1380 by 1382 pixels: 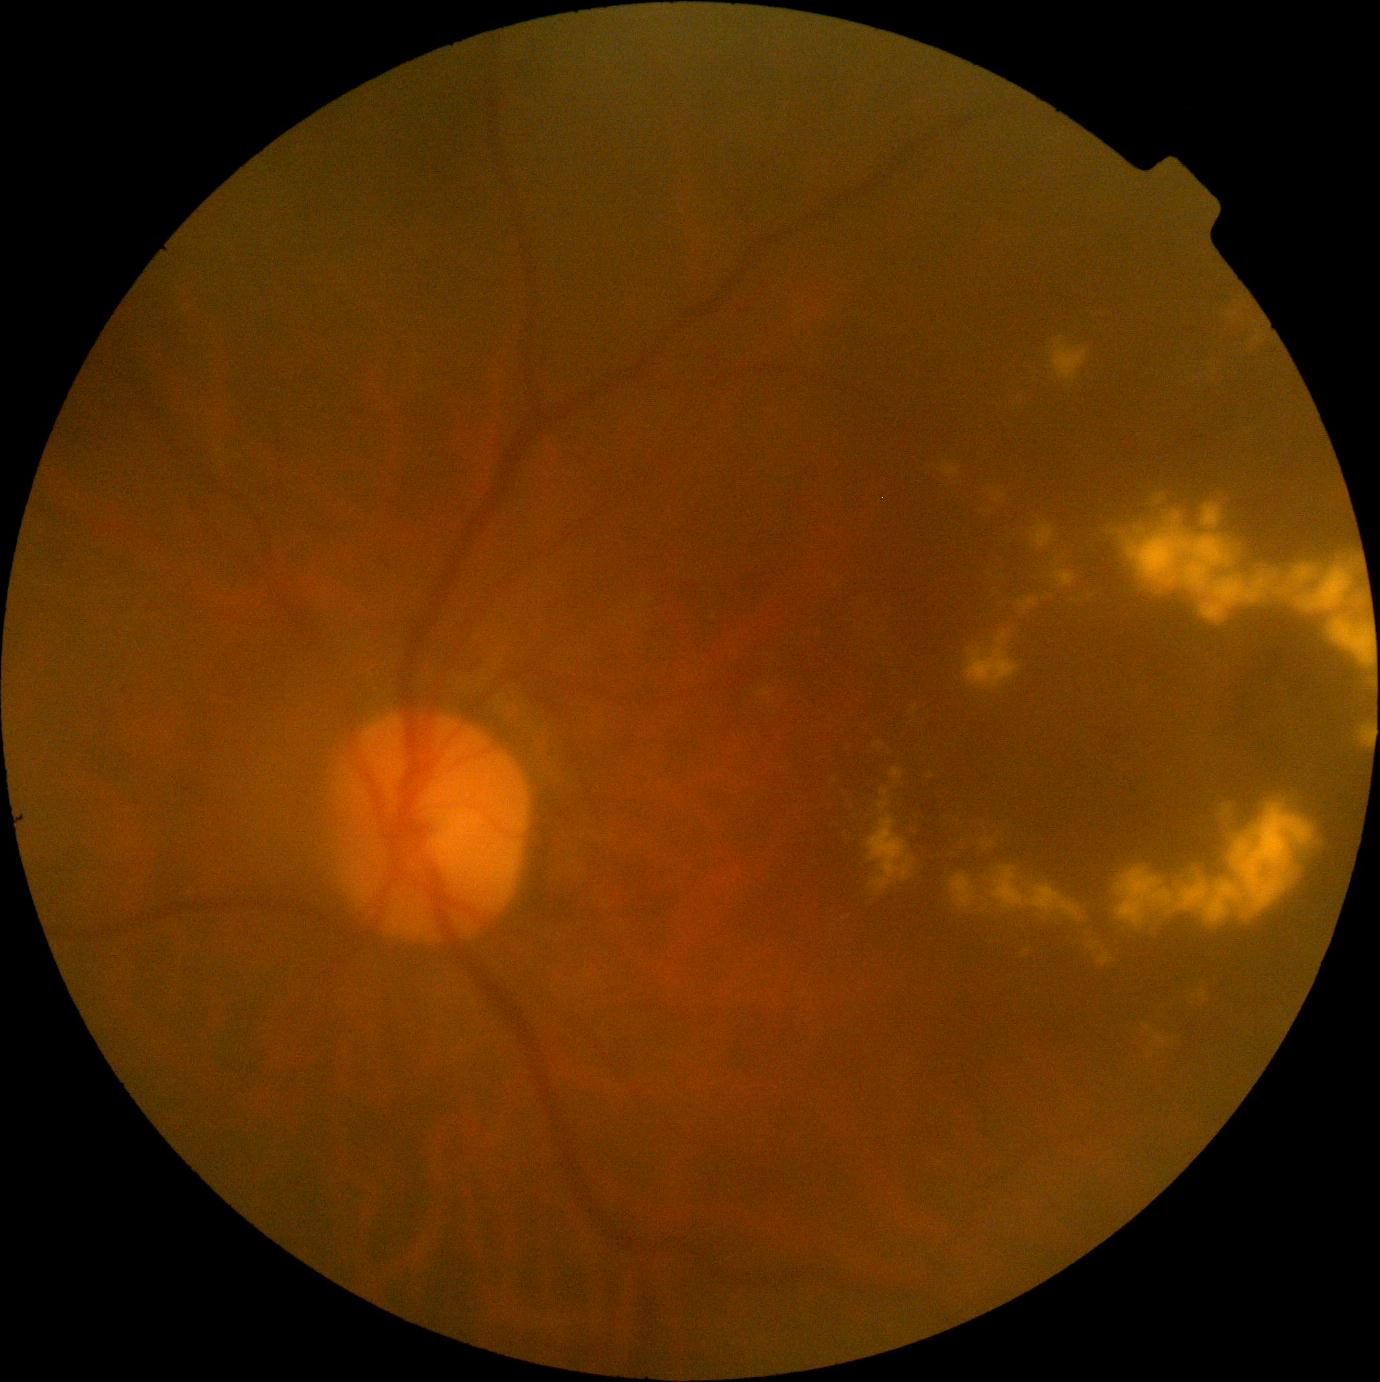

Diabetic retinopathy (DR): grade 2. The retinopathy is classified as non-proliferative diabetic retinopathy.